Fundus photo.
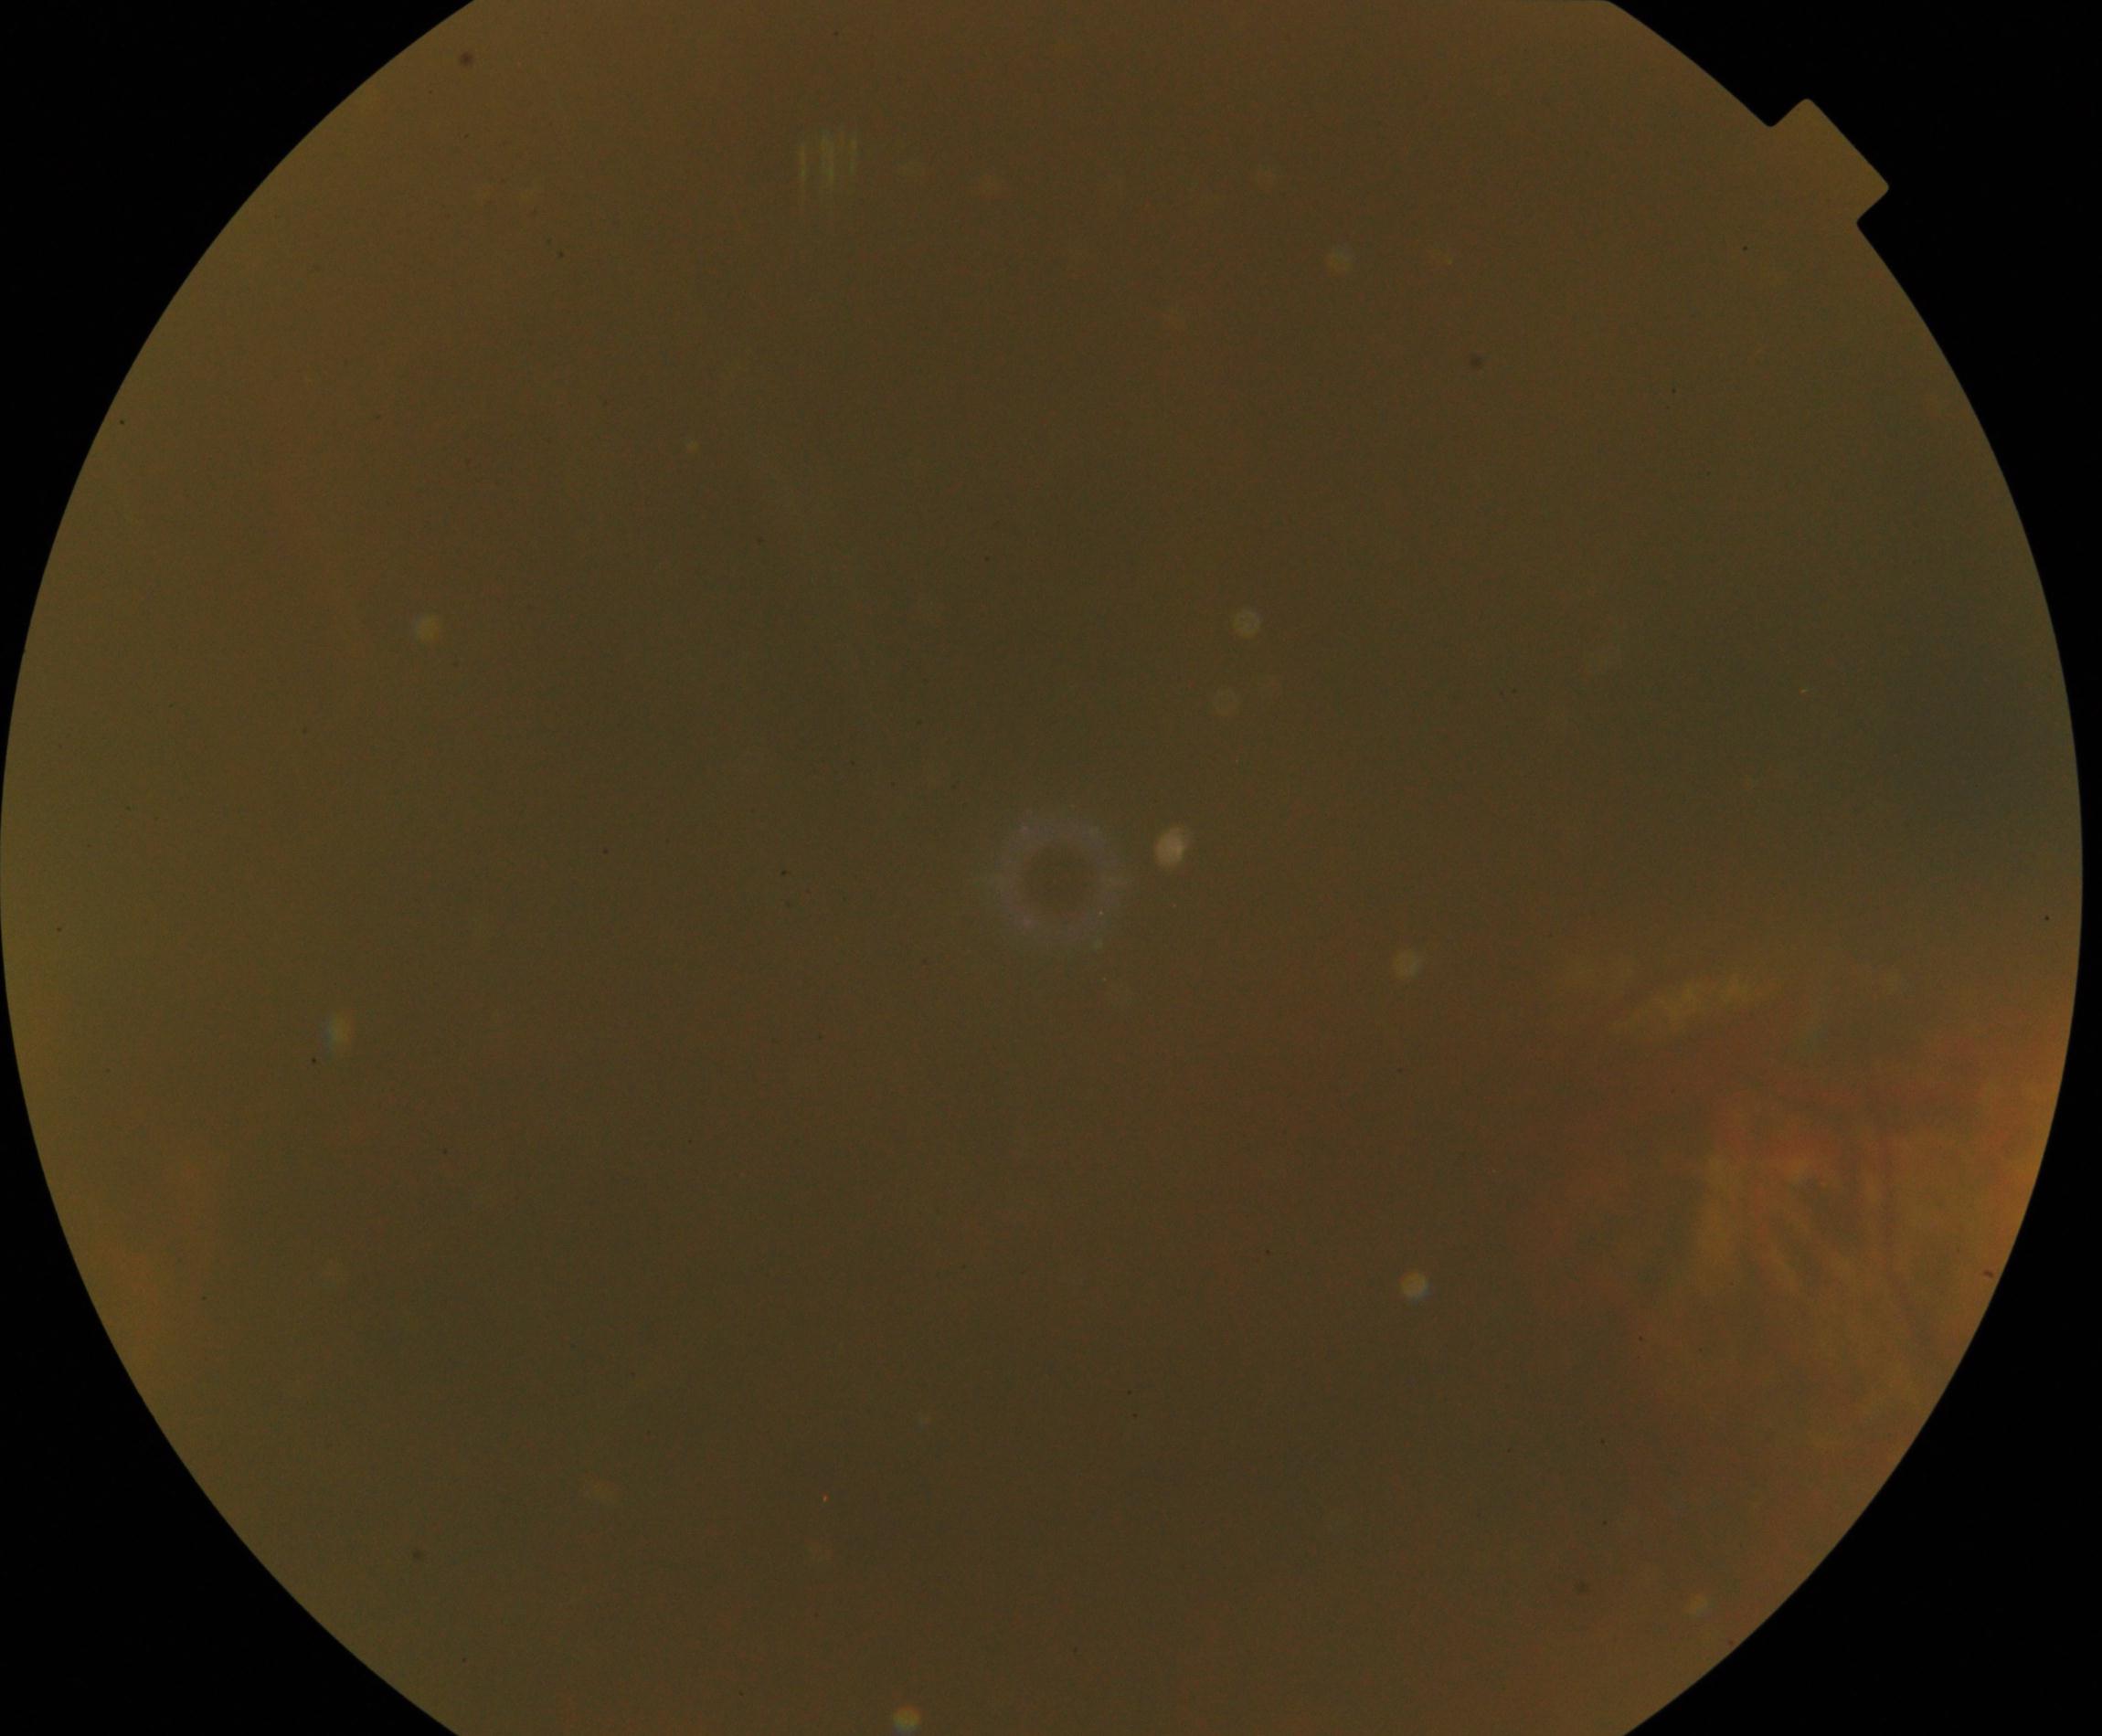 Image is blurred; retinal landmarks are largely obscured. No proliferative diabetic retinopathy identified.